Nonmydriatic fundus photograph. NIDEK AFC-230 — 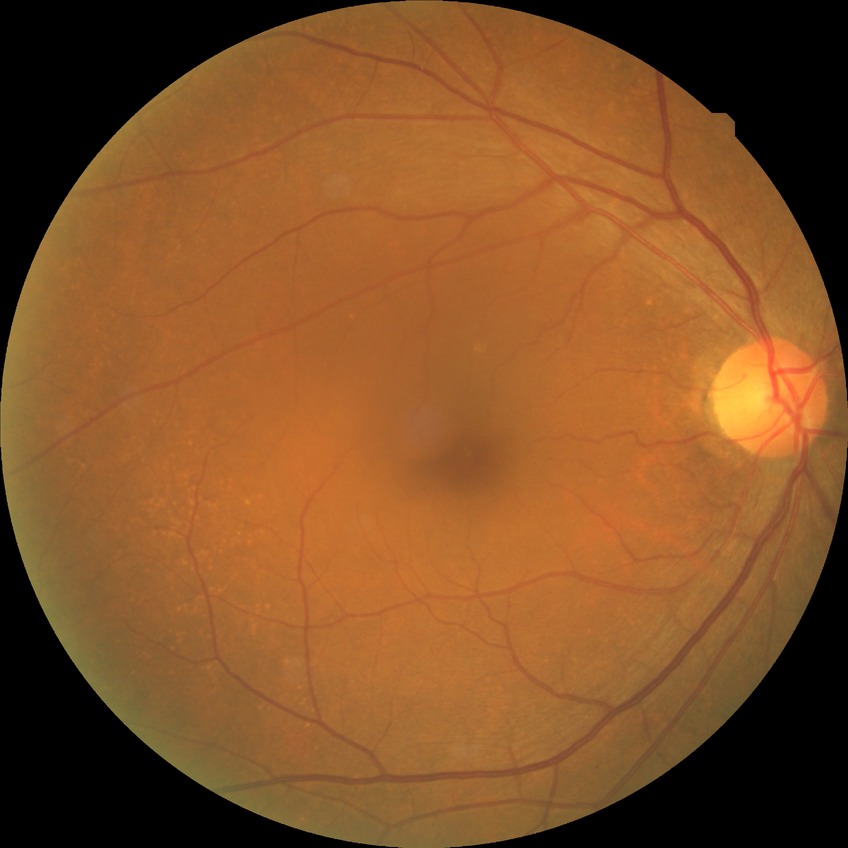 Modified Davis grading: no diabetic retinopathy.